Ultra-widefield fundus photograph
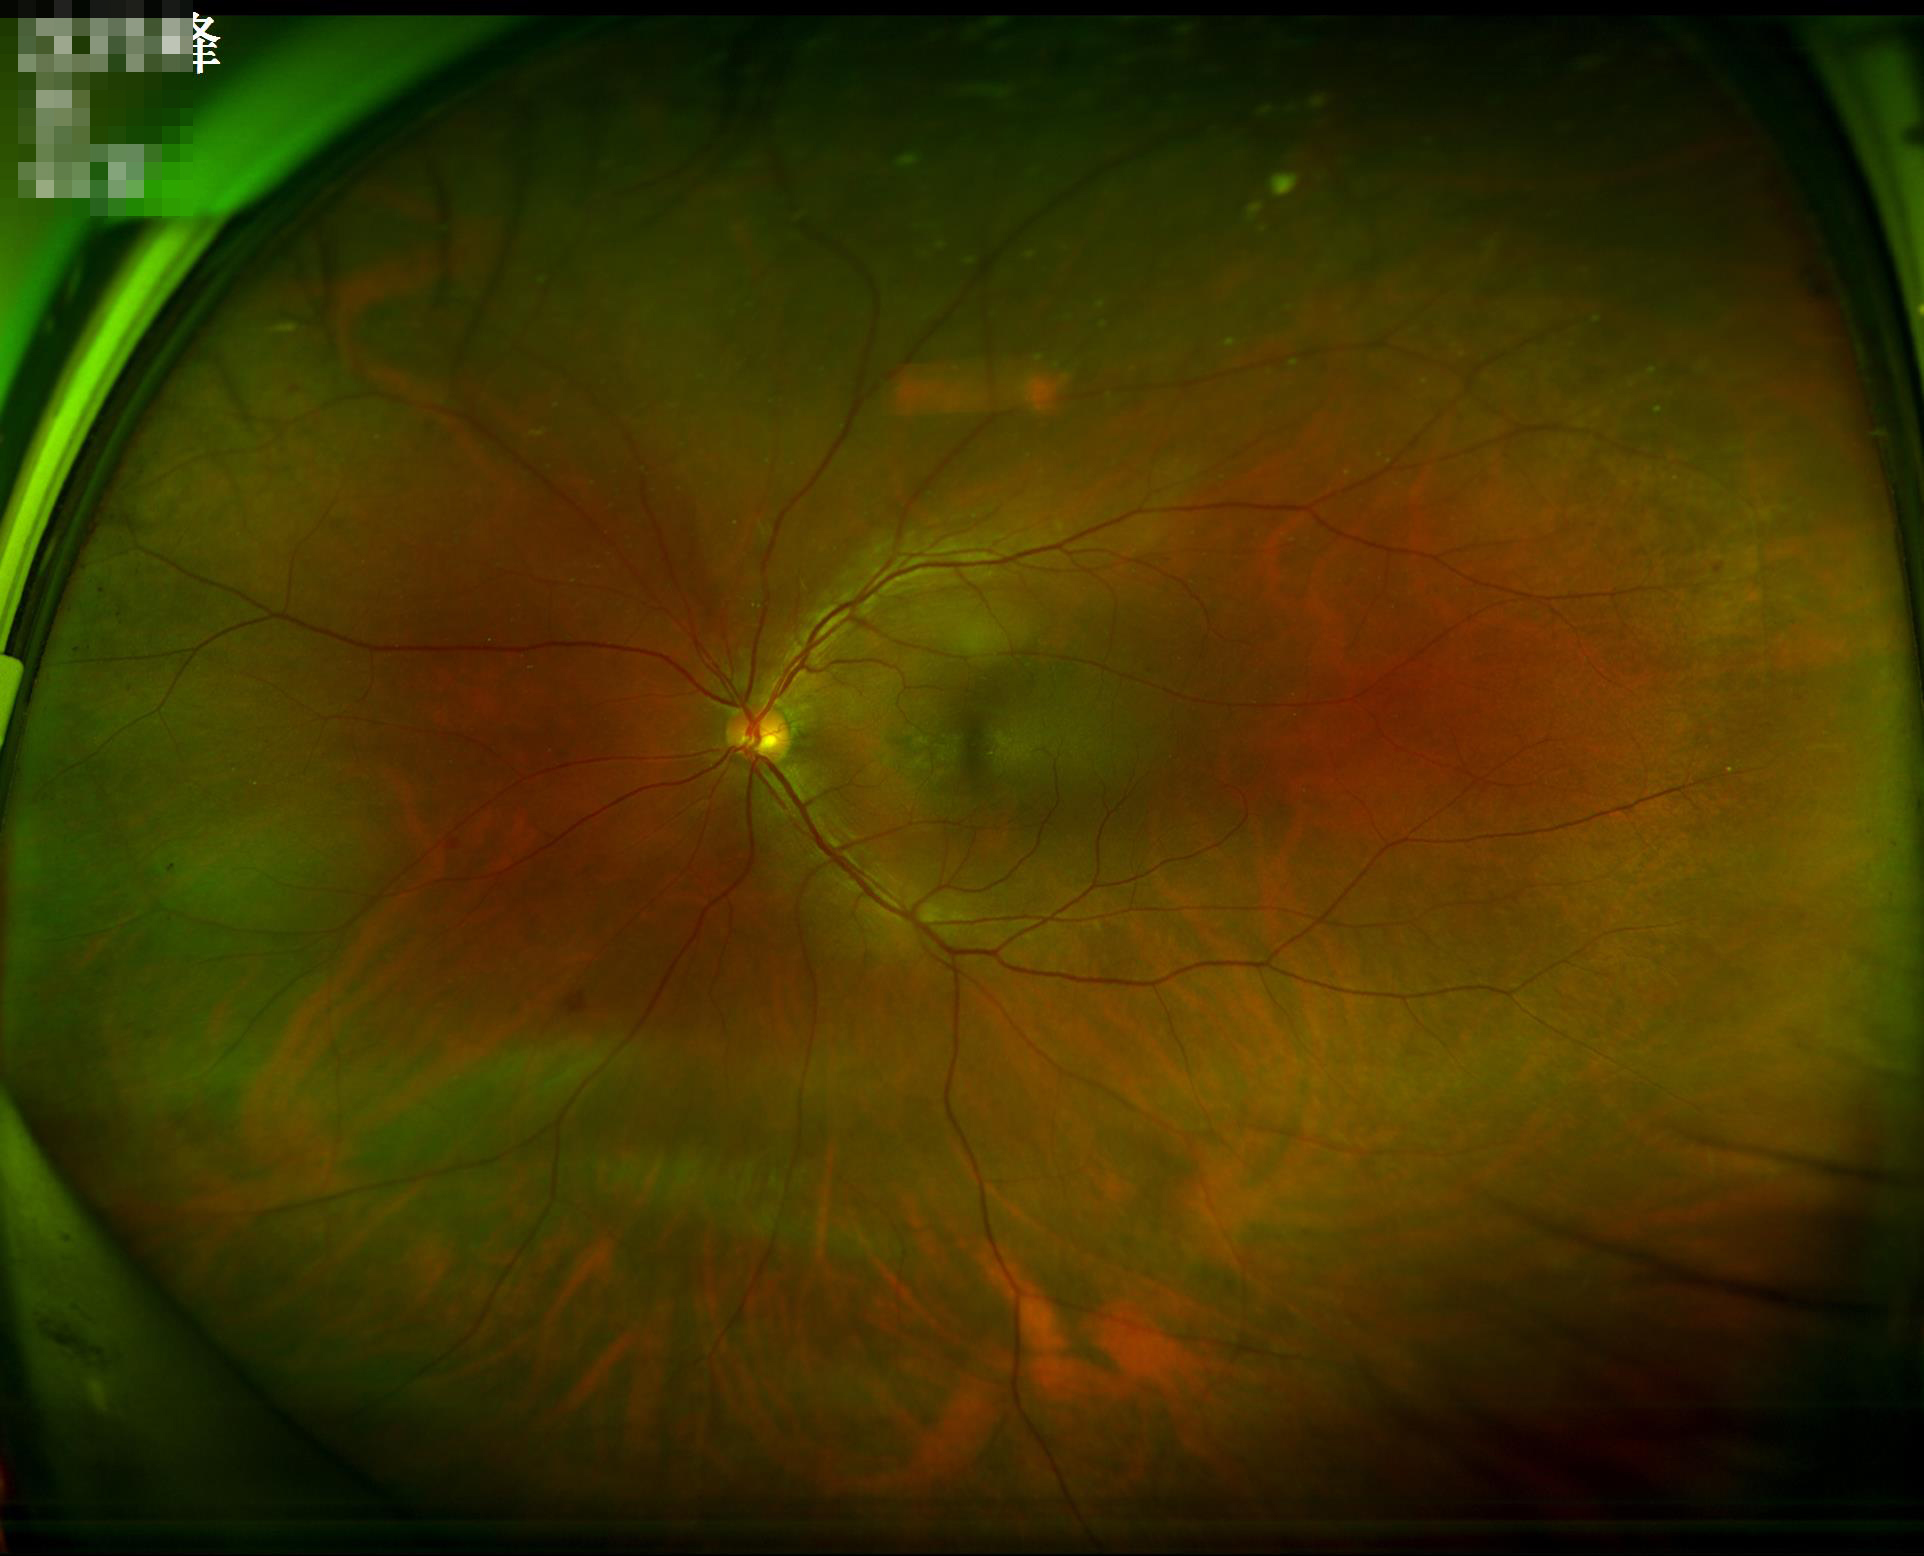

Optic disc, vessels, and background are in focus.
Overall image quality is good.